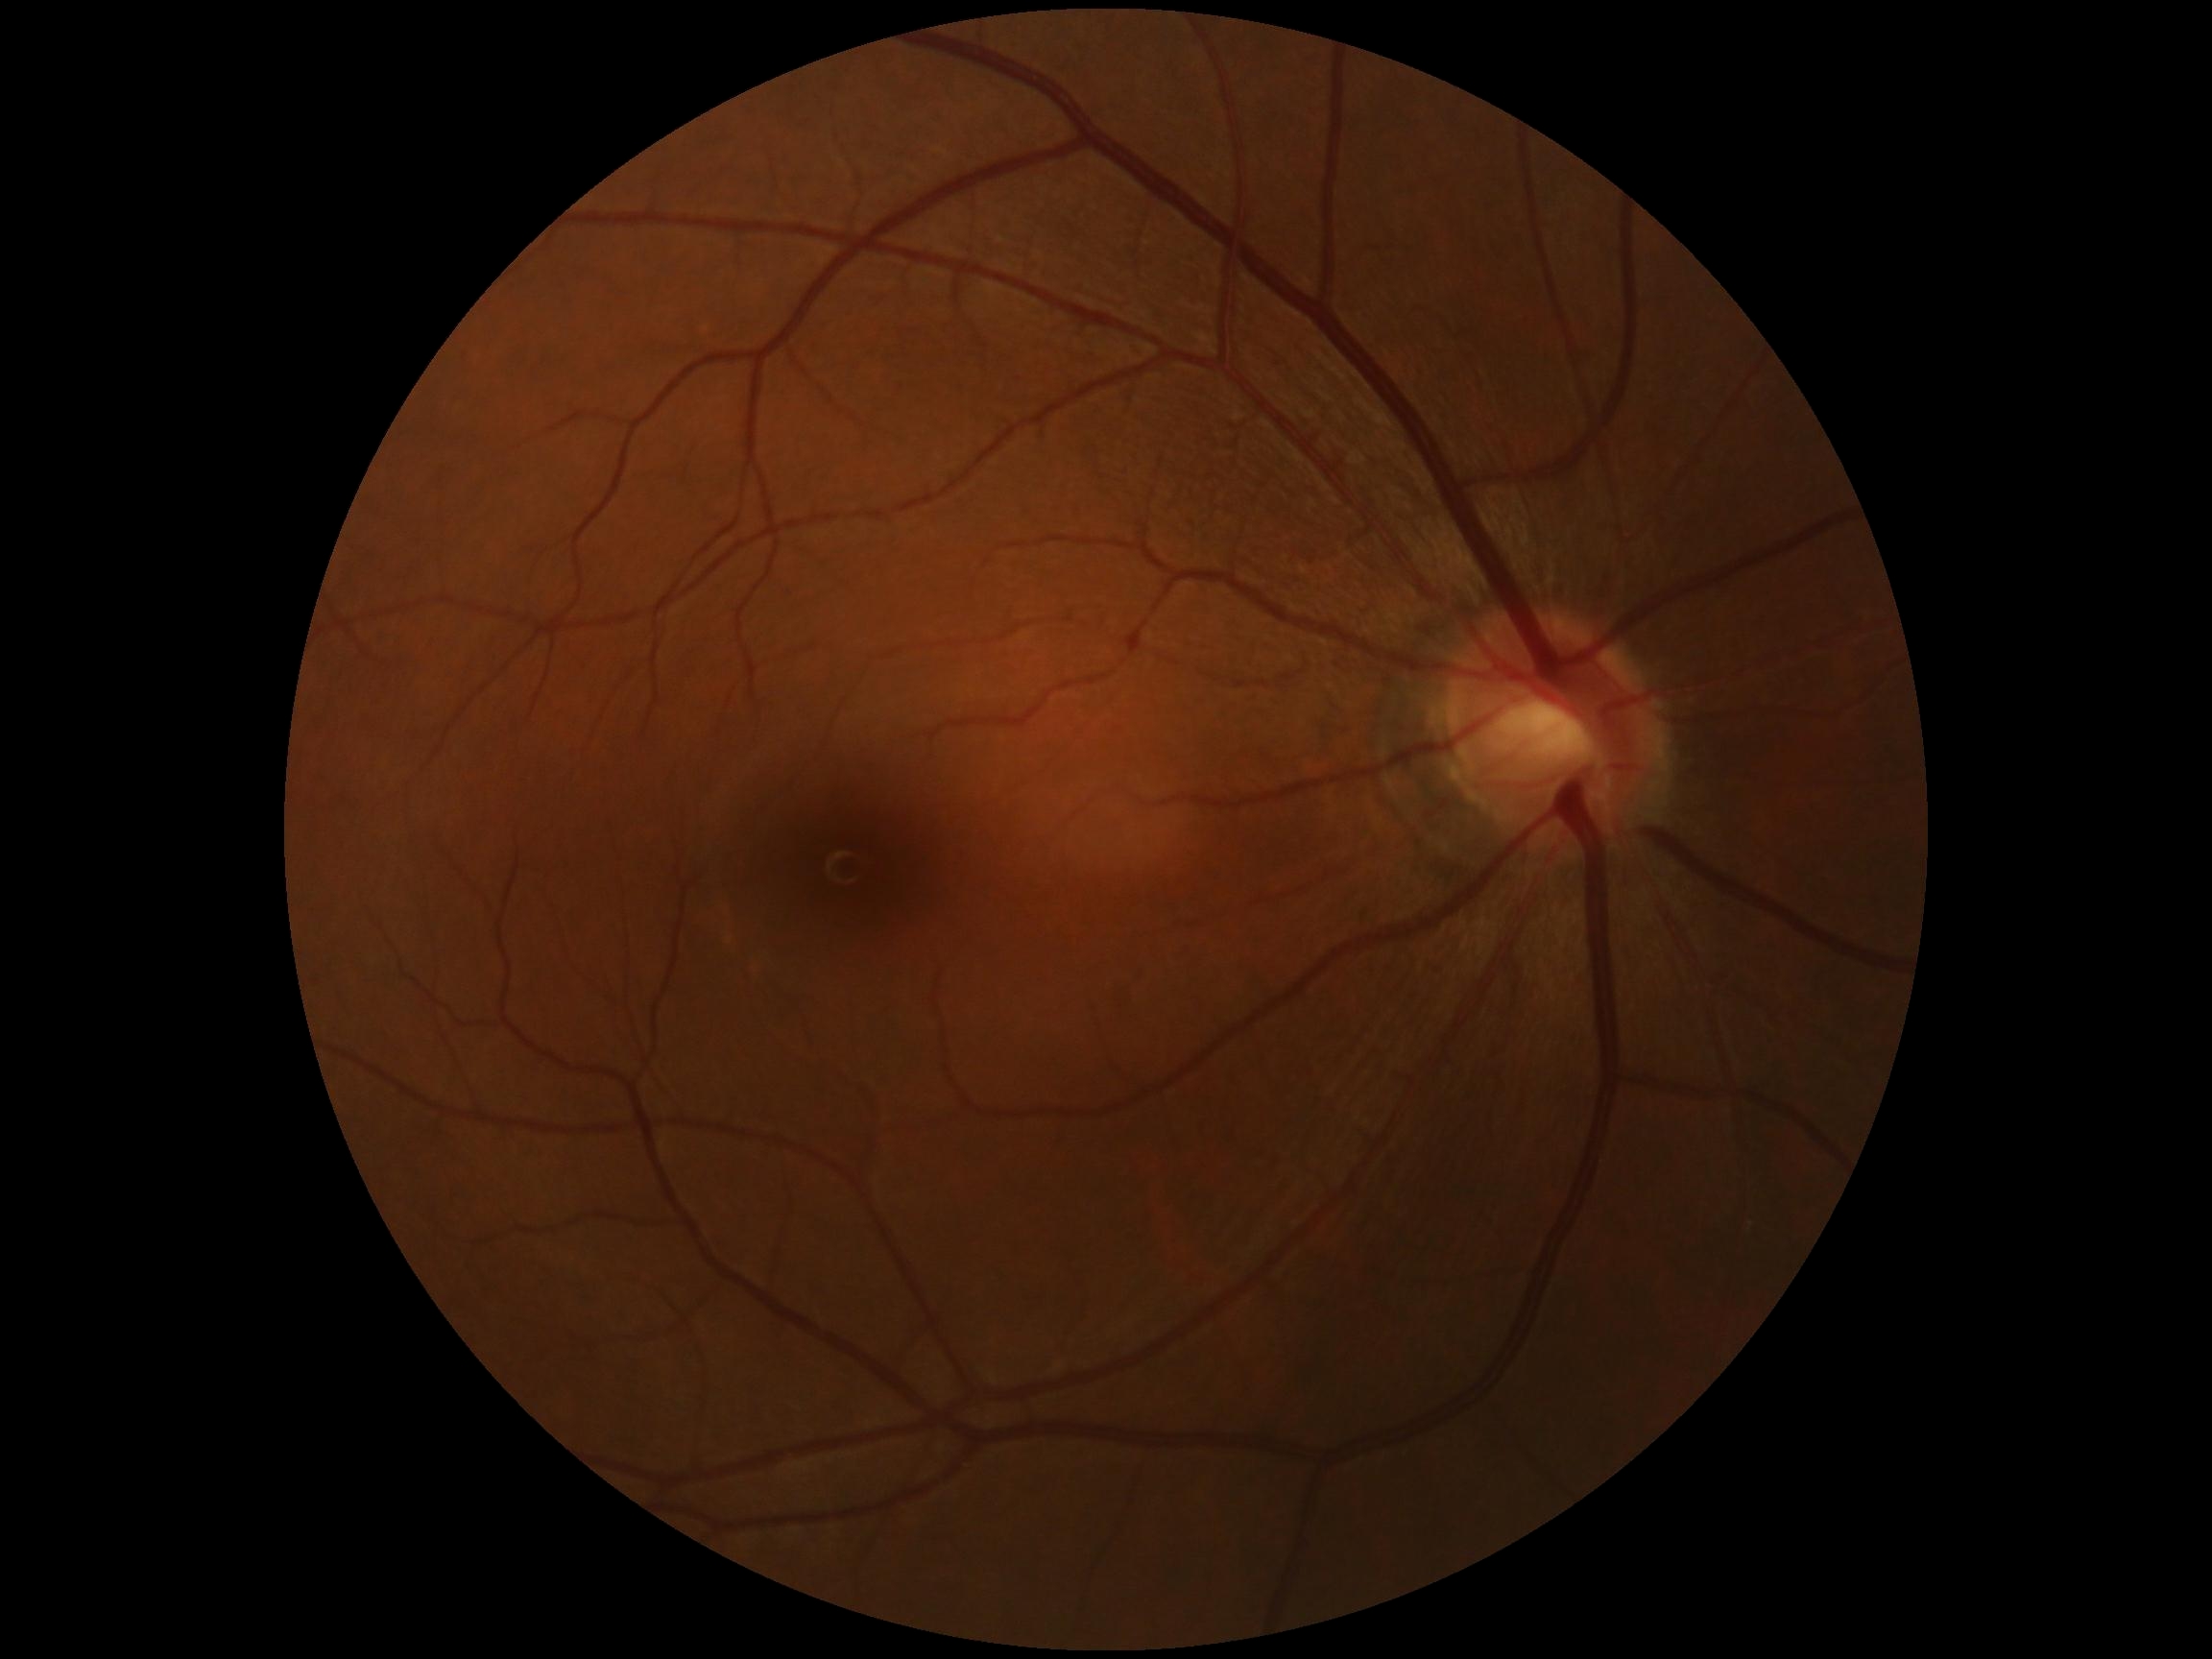
Retinopathy: grade 0.